Fundus photo — 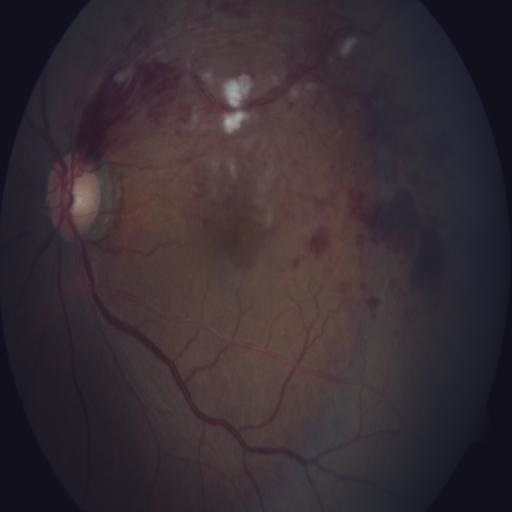 Two abnormalities. There is evidence of branch retinal vein occlusion and cotton wool spots.